Image size 1240x1240; wide-field fundus photograph from neonatal ROP screening: 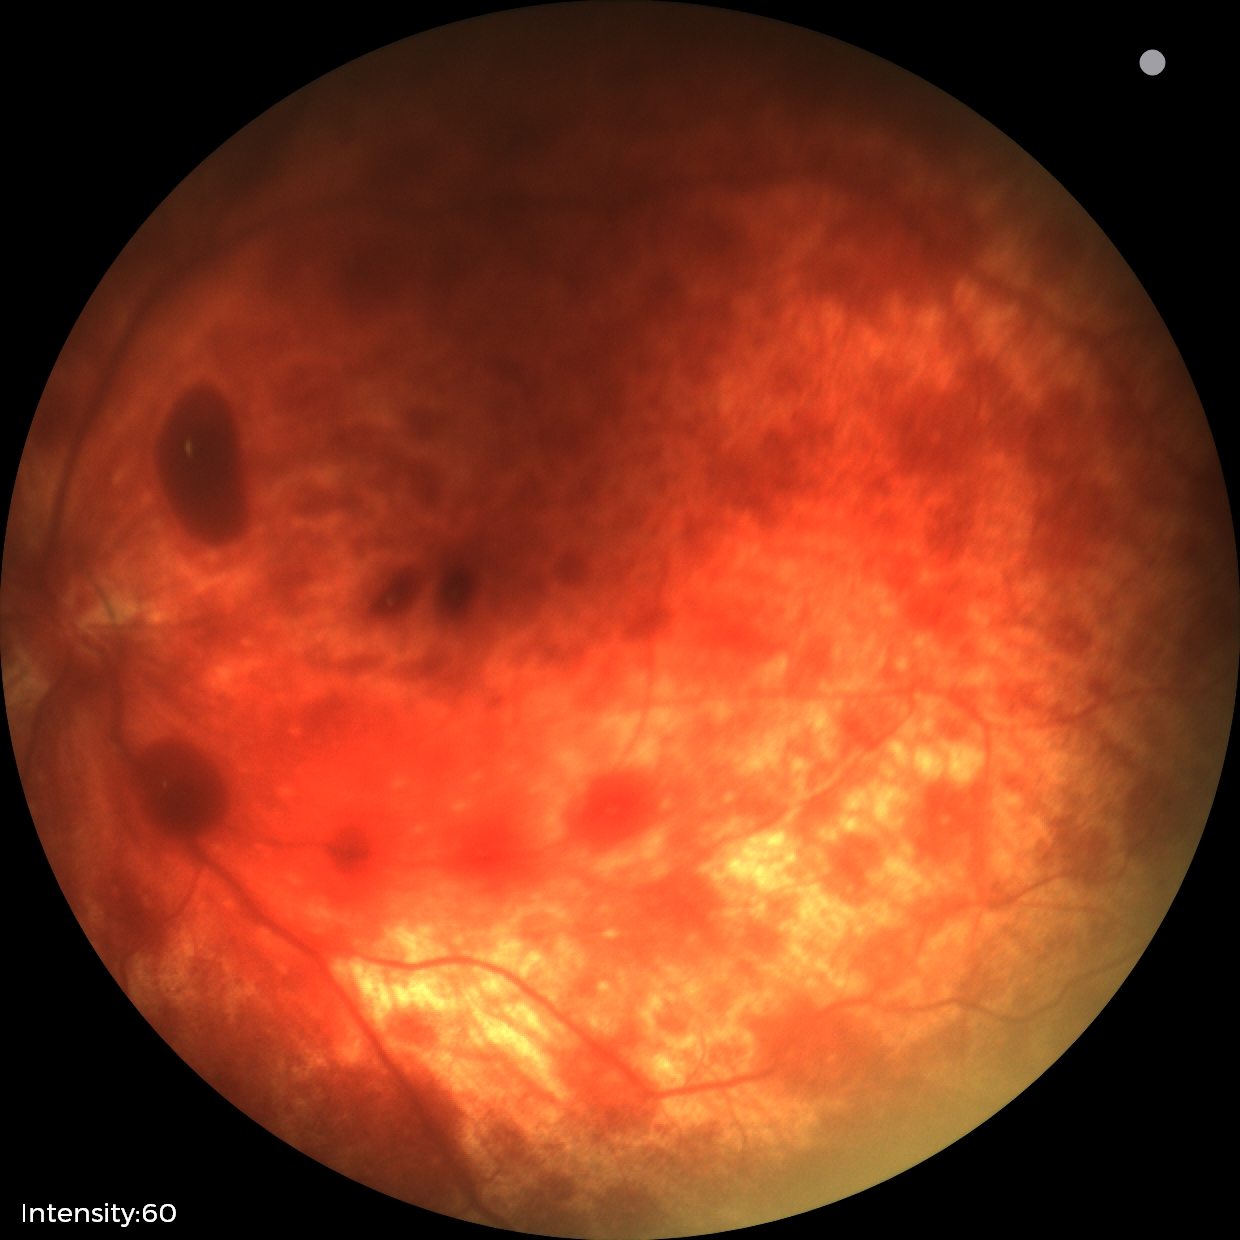
Assessment: retinal hemorrhages.